Acquired with a NIDEK AFC-230 · Davis DR grading:
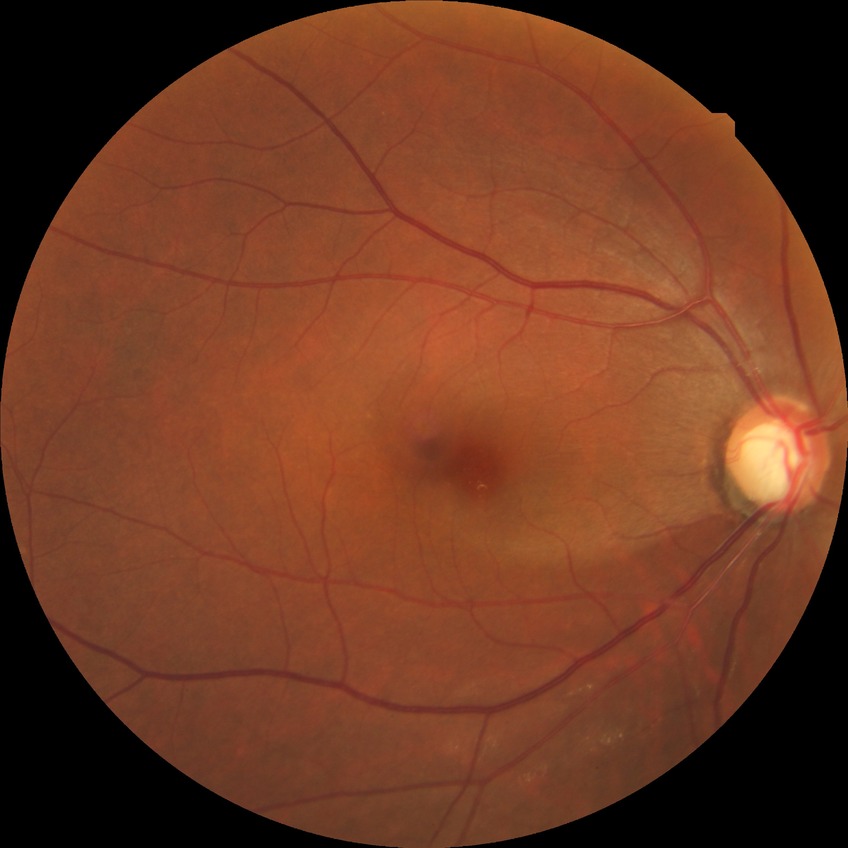

diabetic retinopathy (DR)=no diabetic retinopathy (NDR).